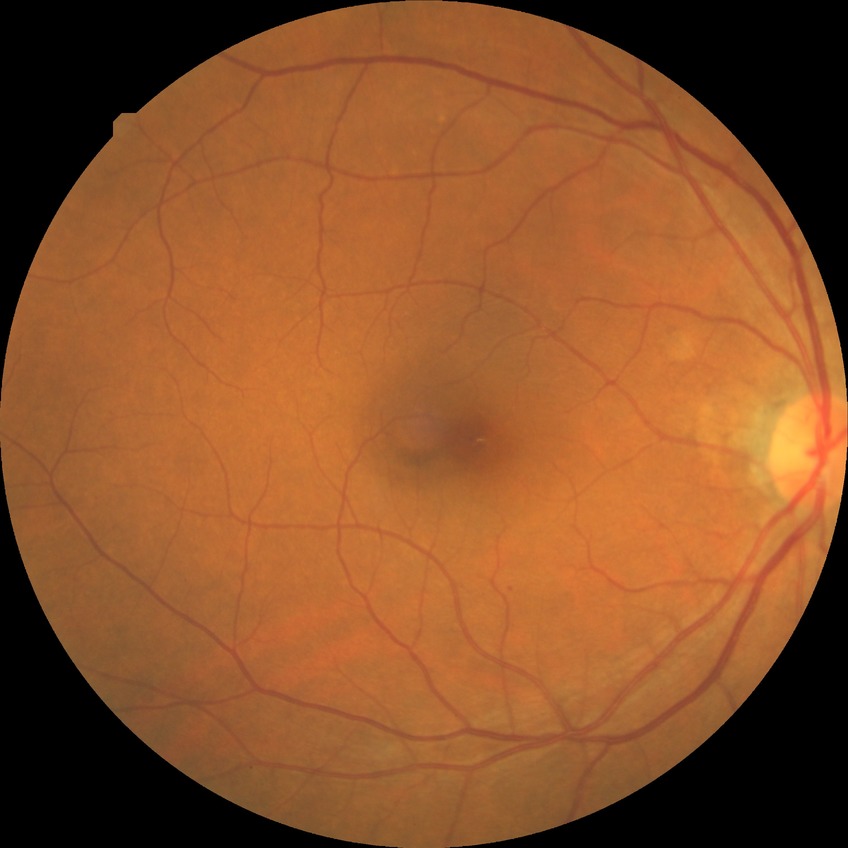
Diabetic retinopathy (DR): no diabetic retinopathy (NDR).